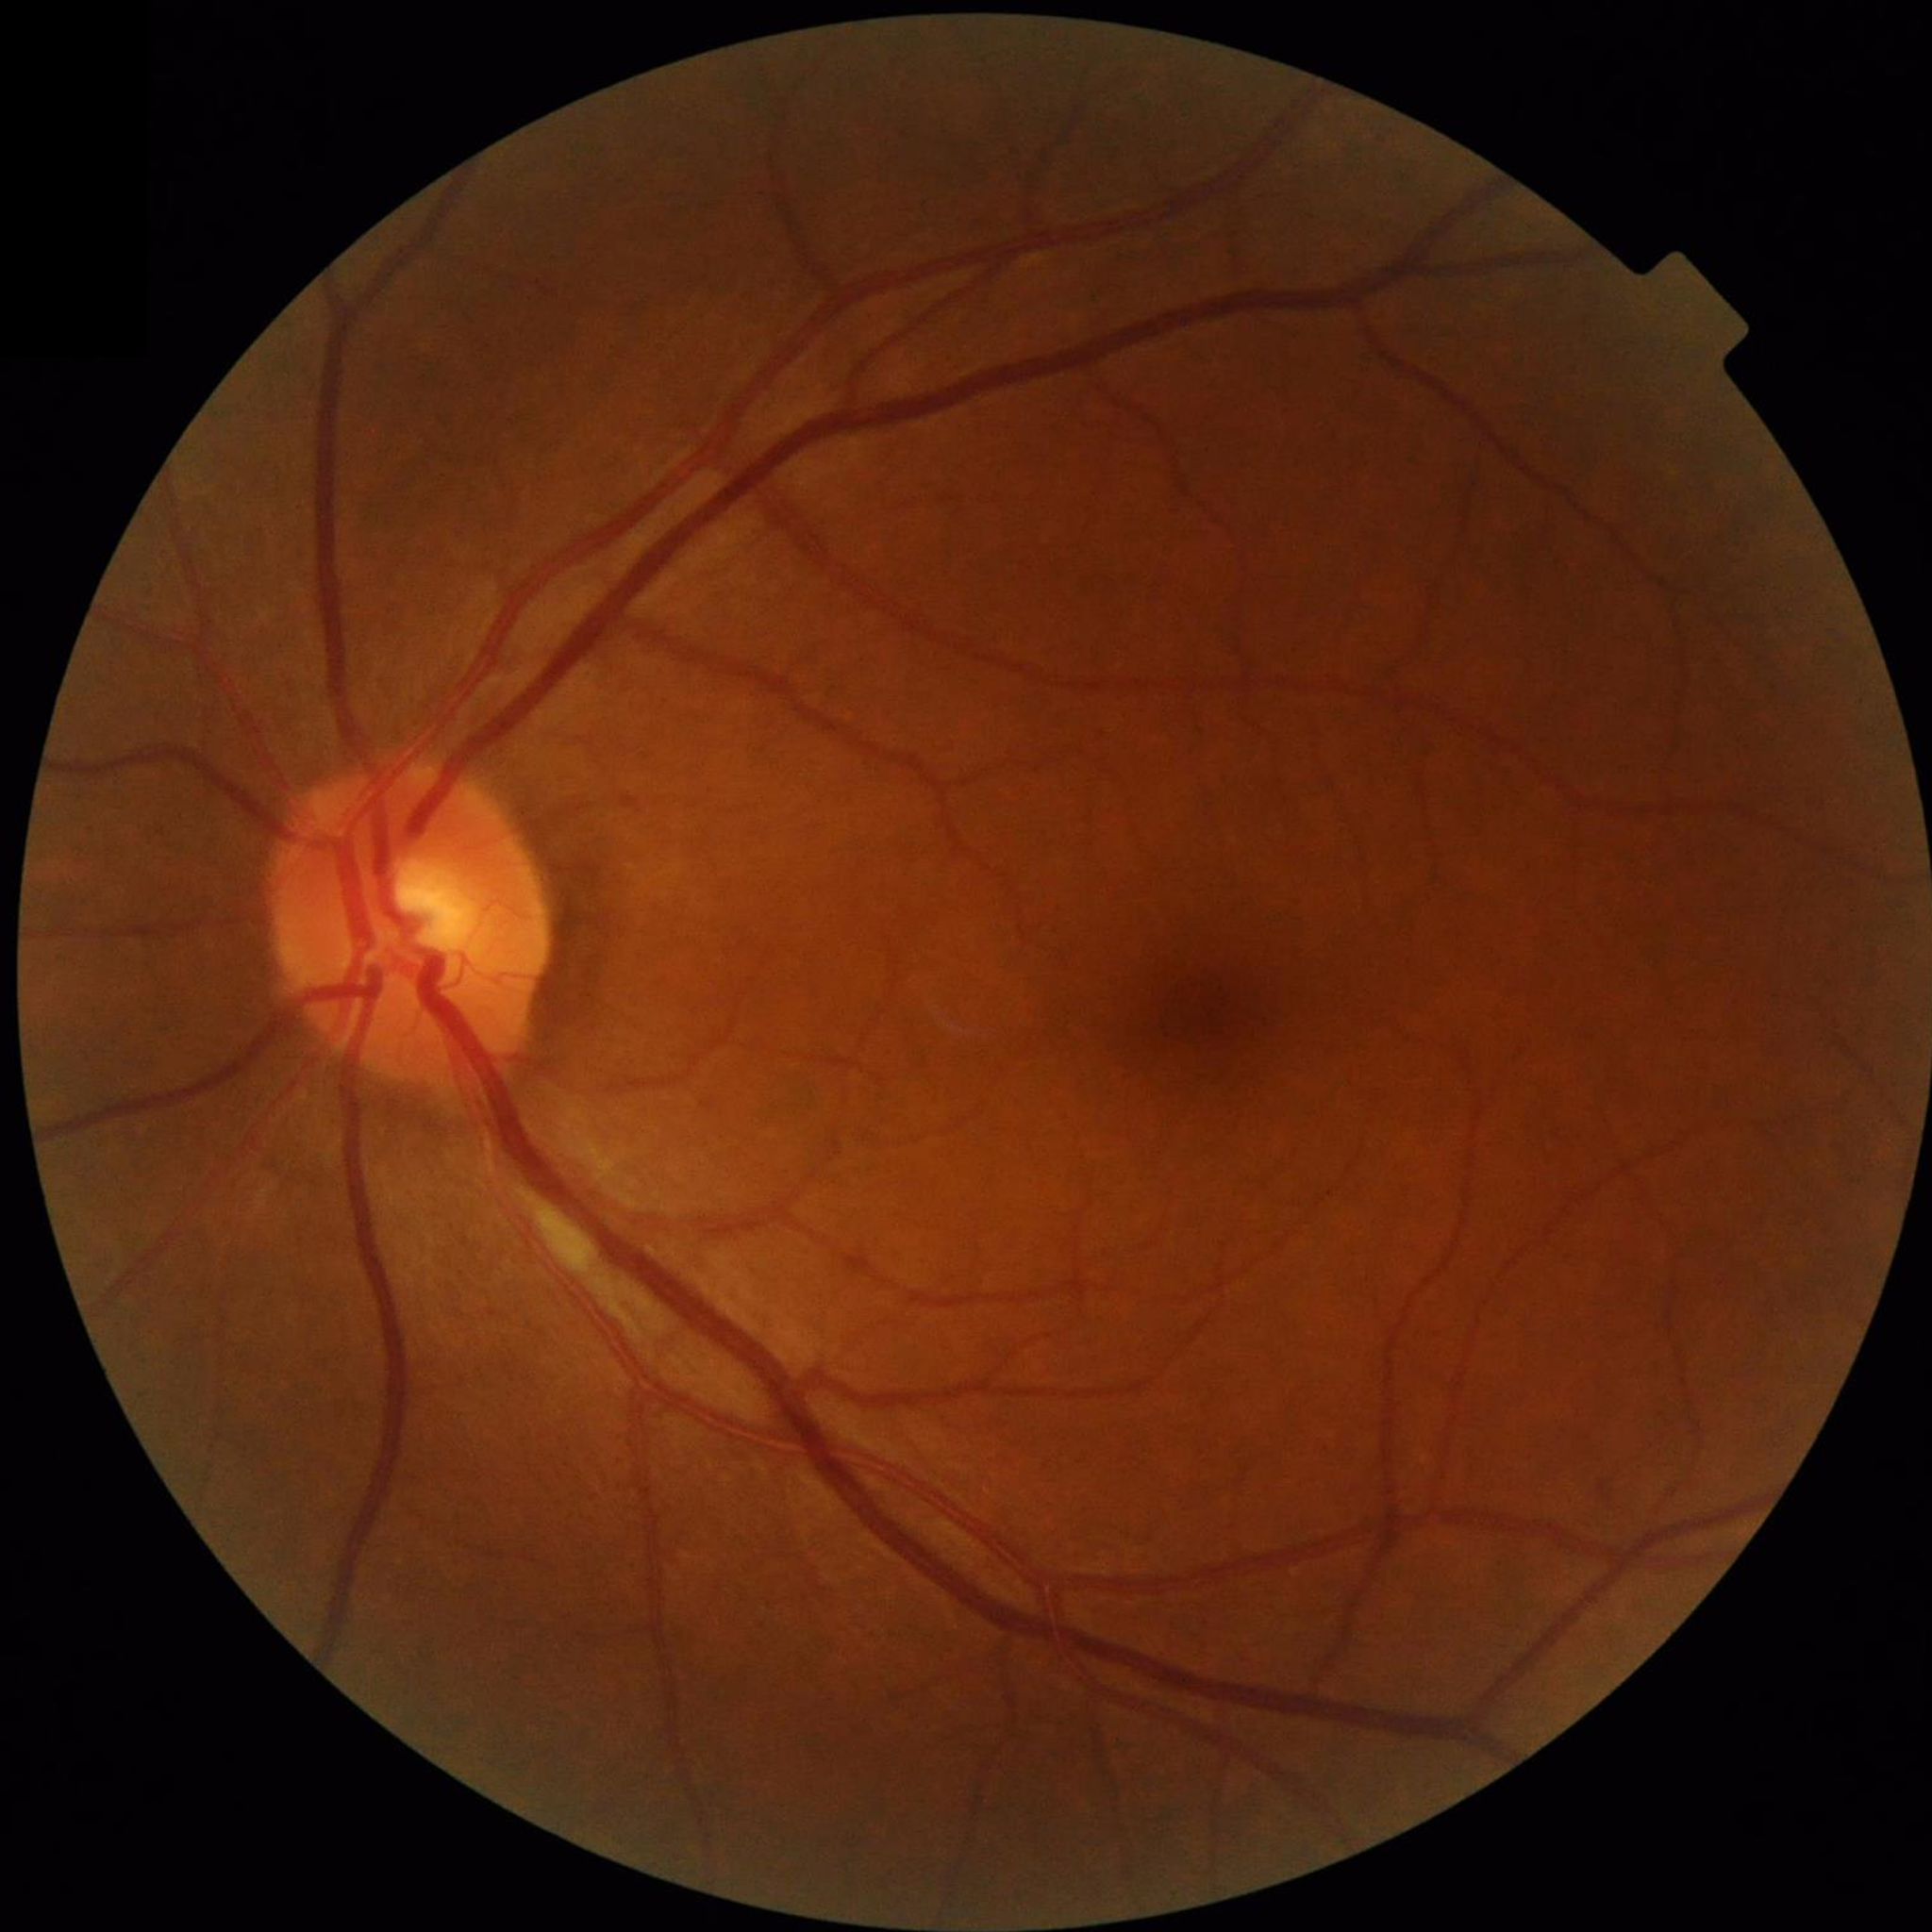
No AMD, DR, or glaucomatous findings.